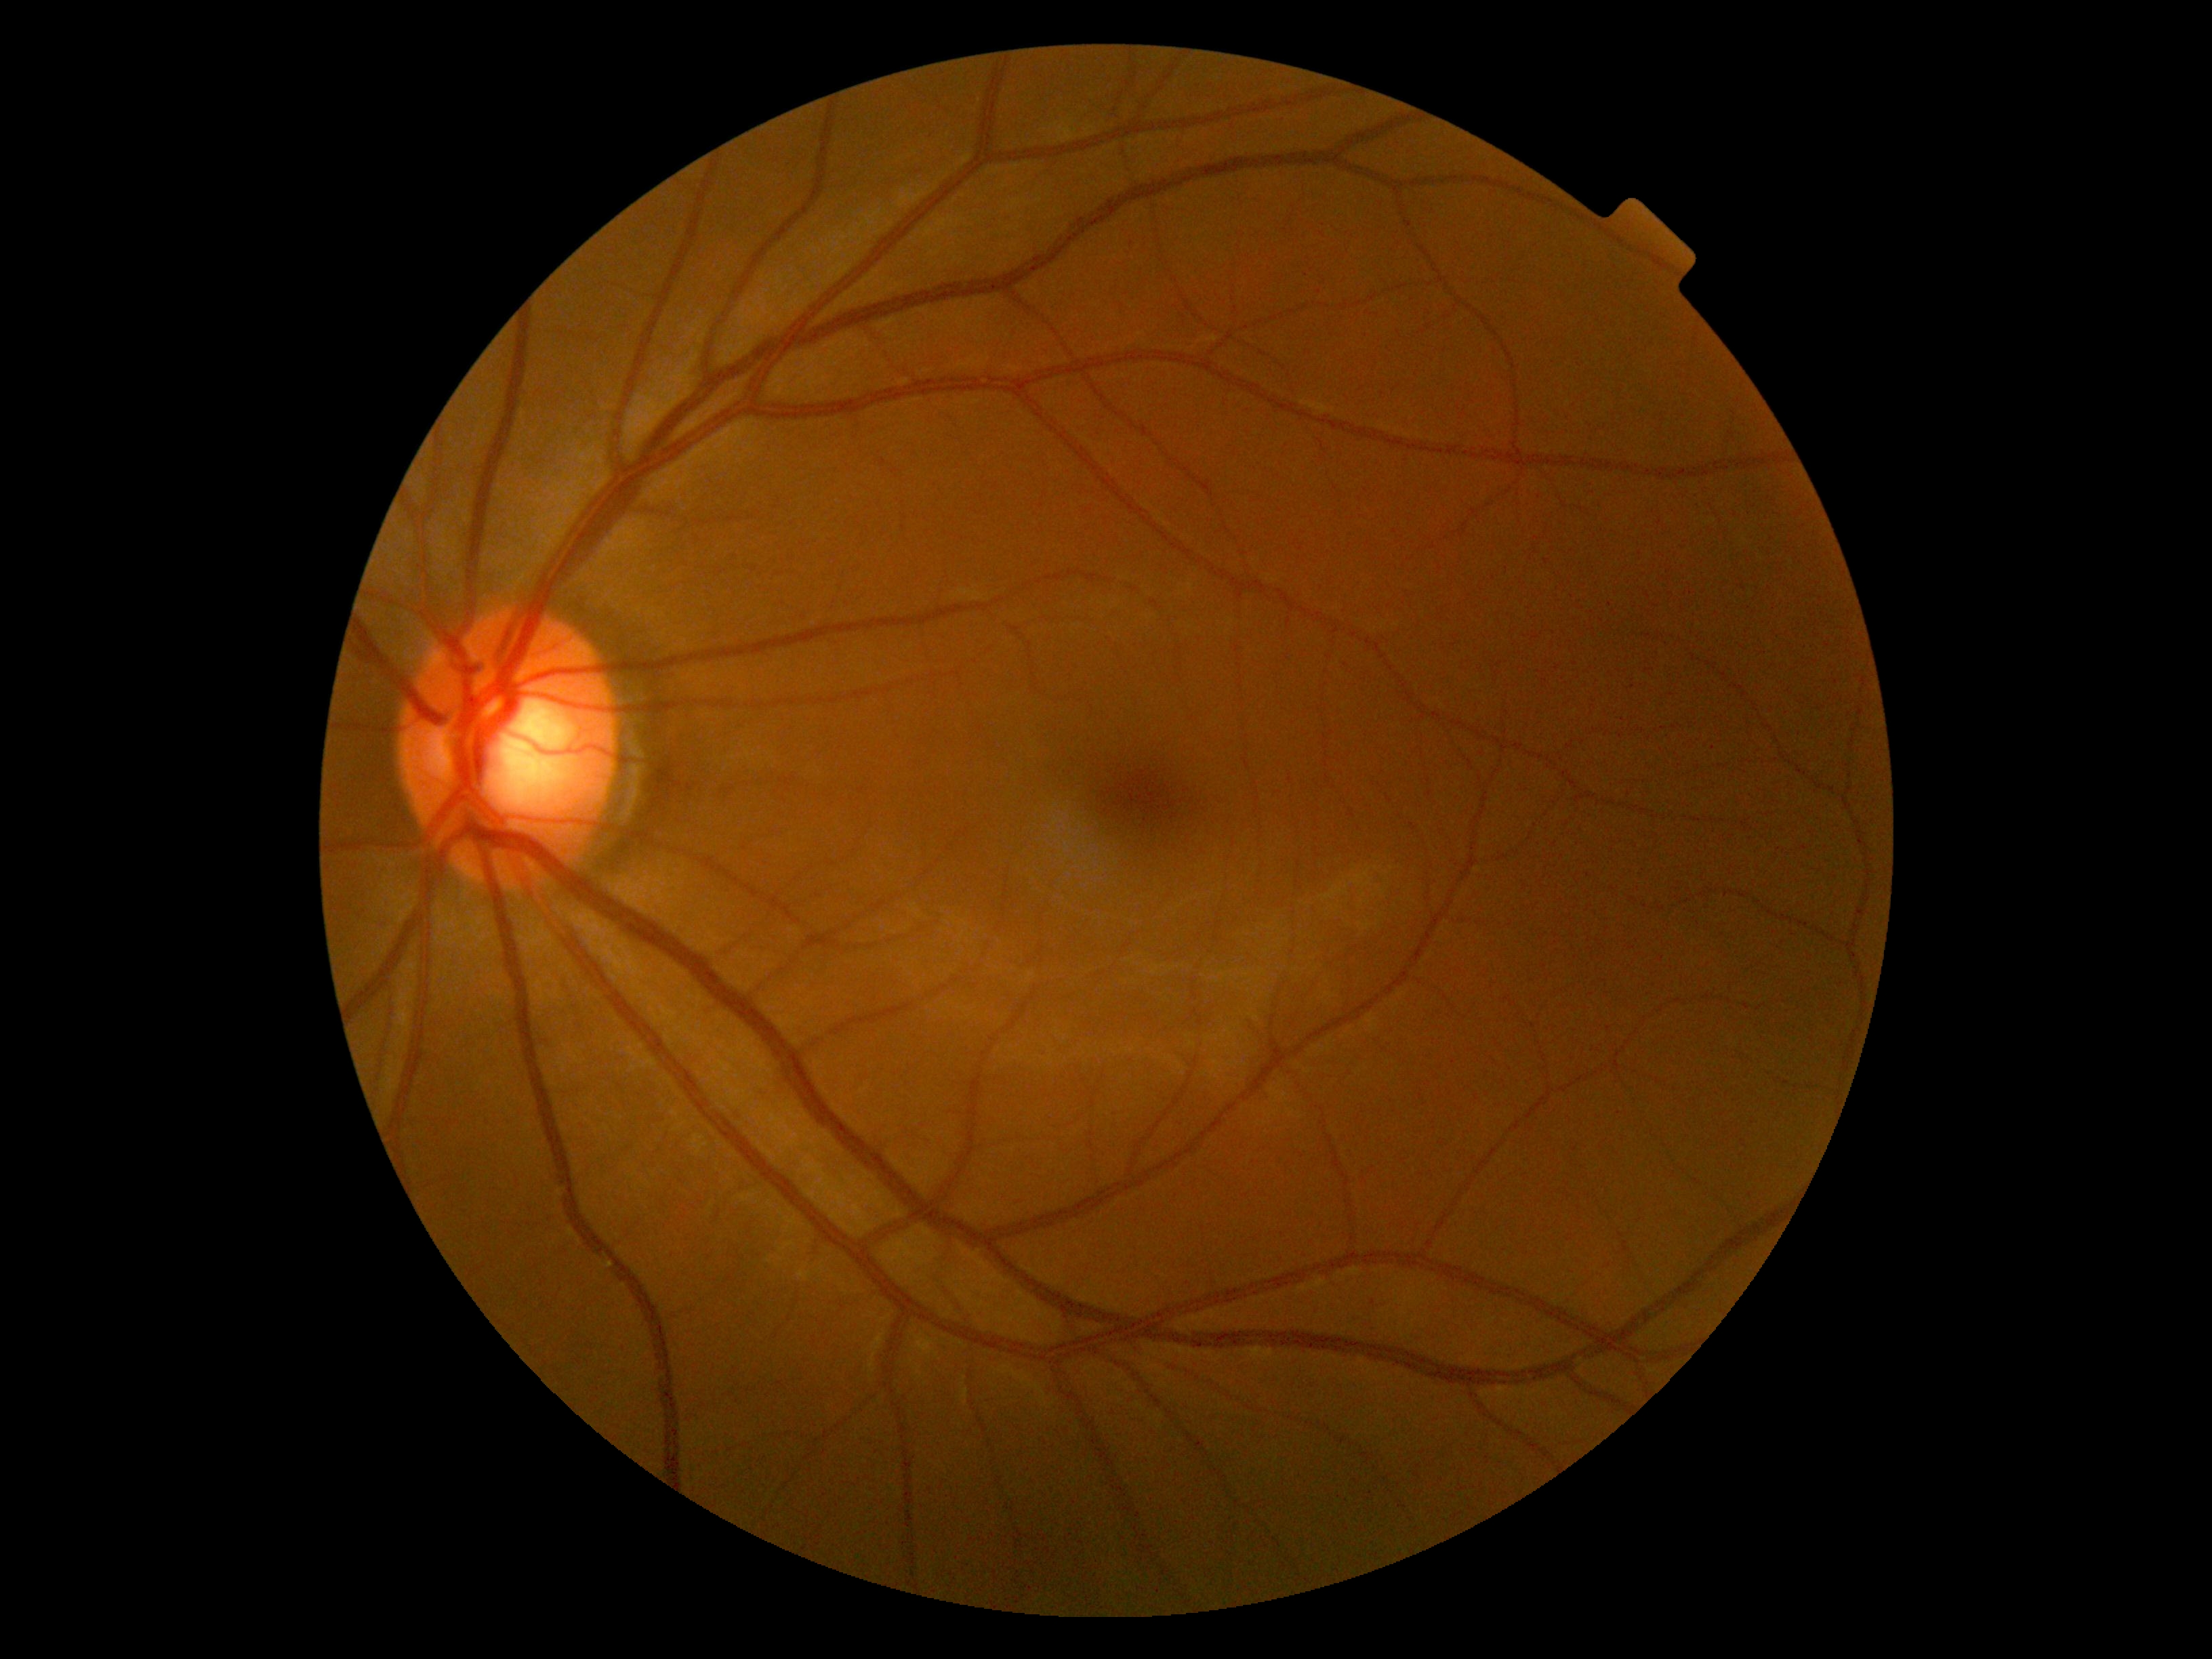 Diabetic retinopathy (DR): no apparent retinopathy (grade 0).